2228 x 1652 pixels.
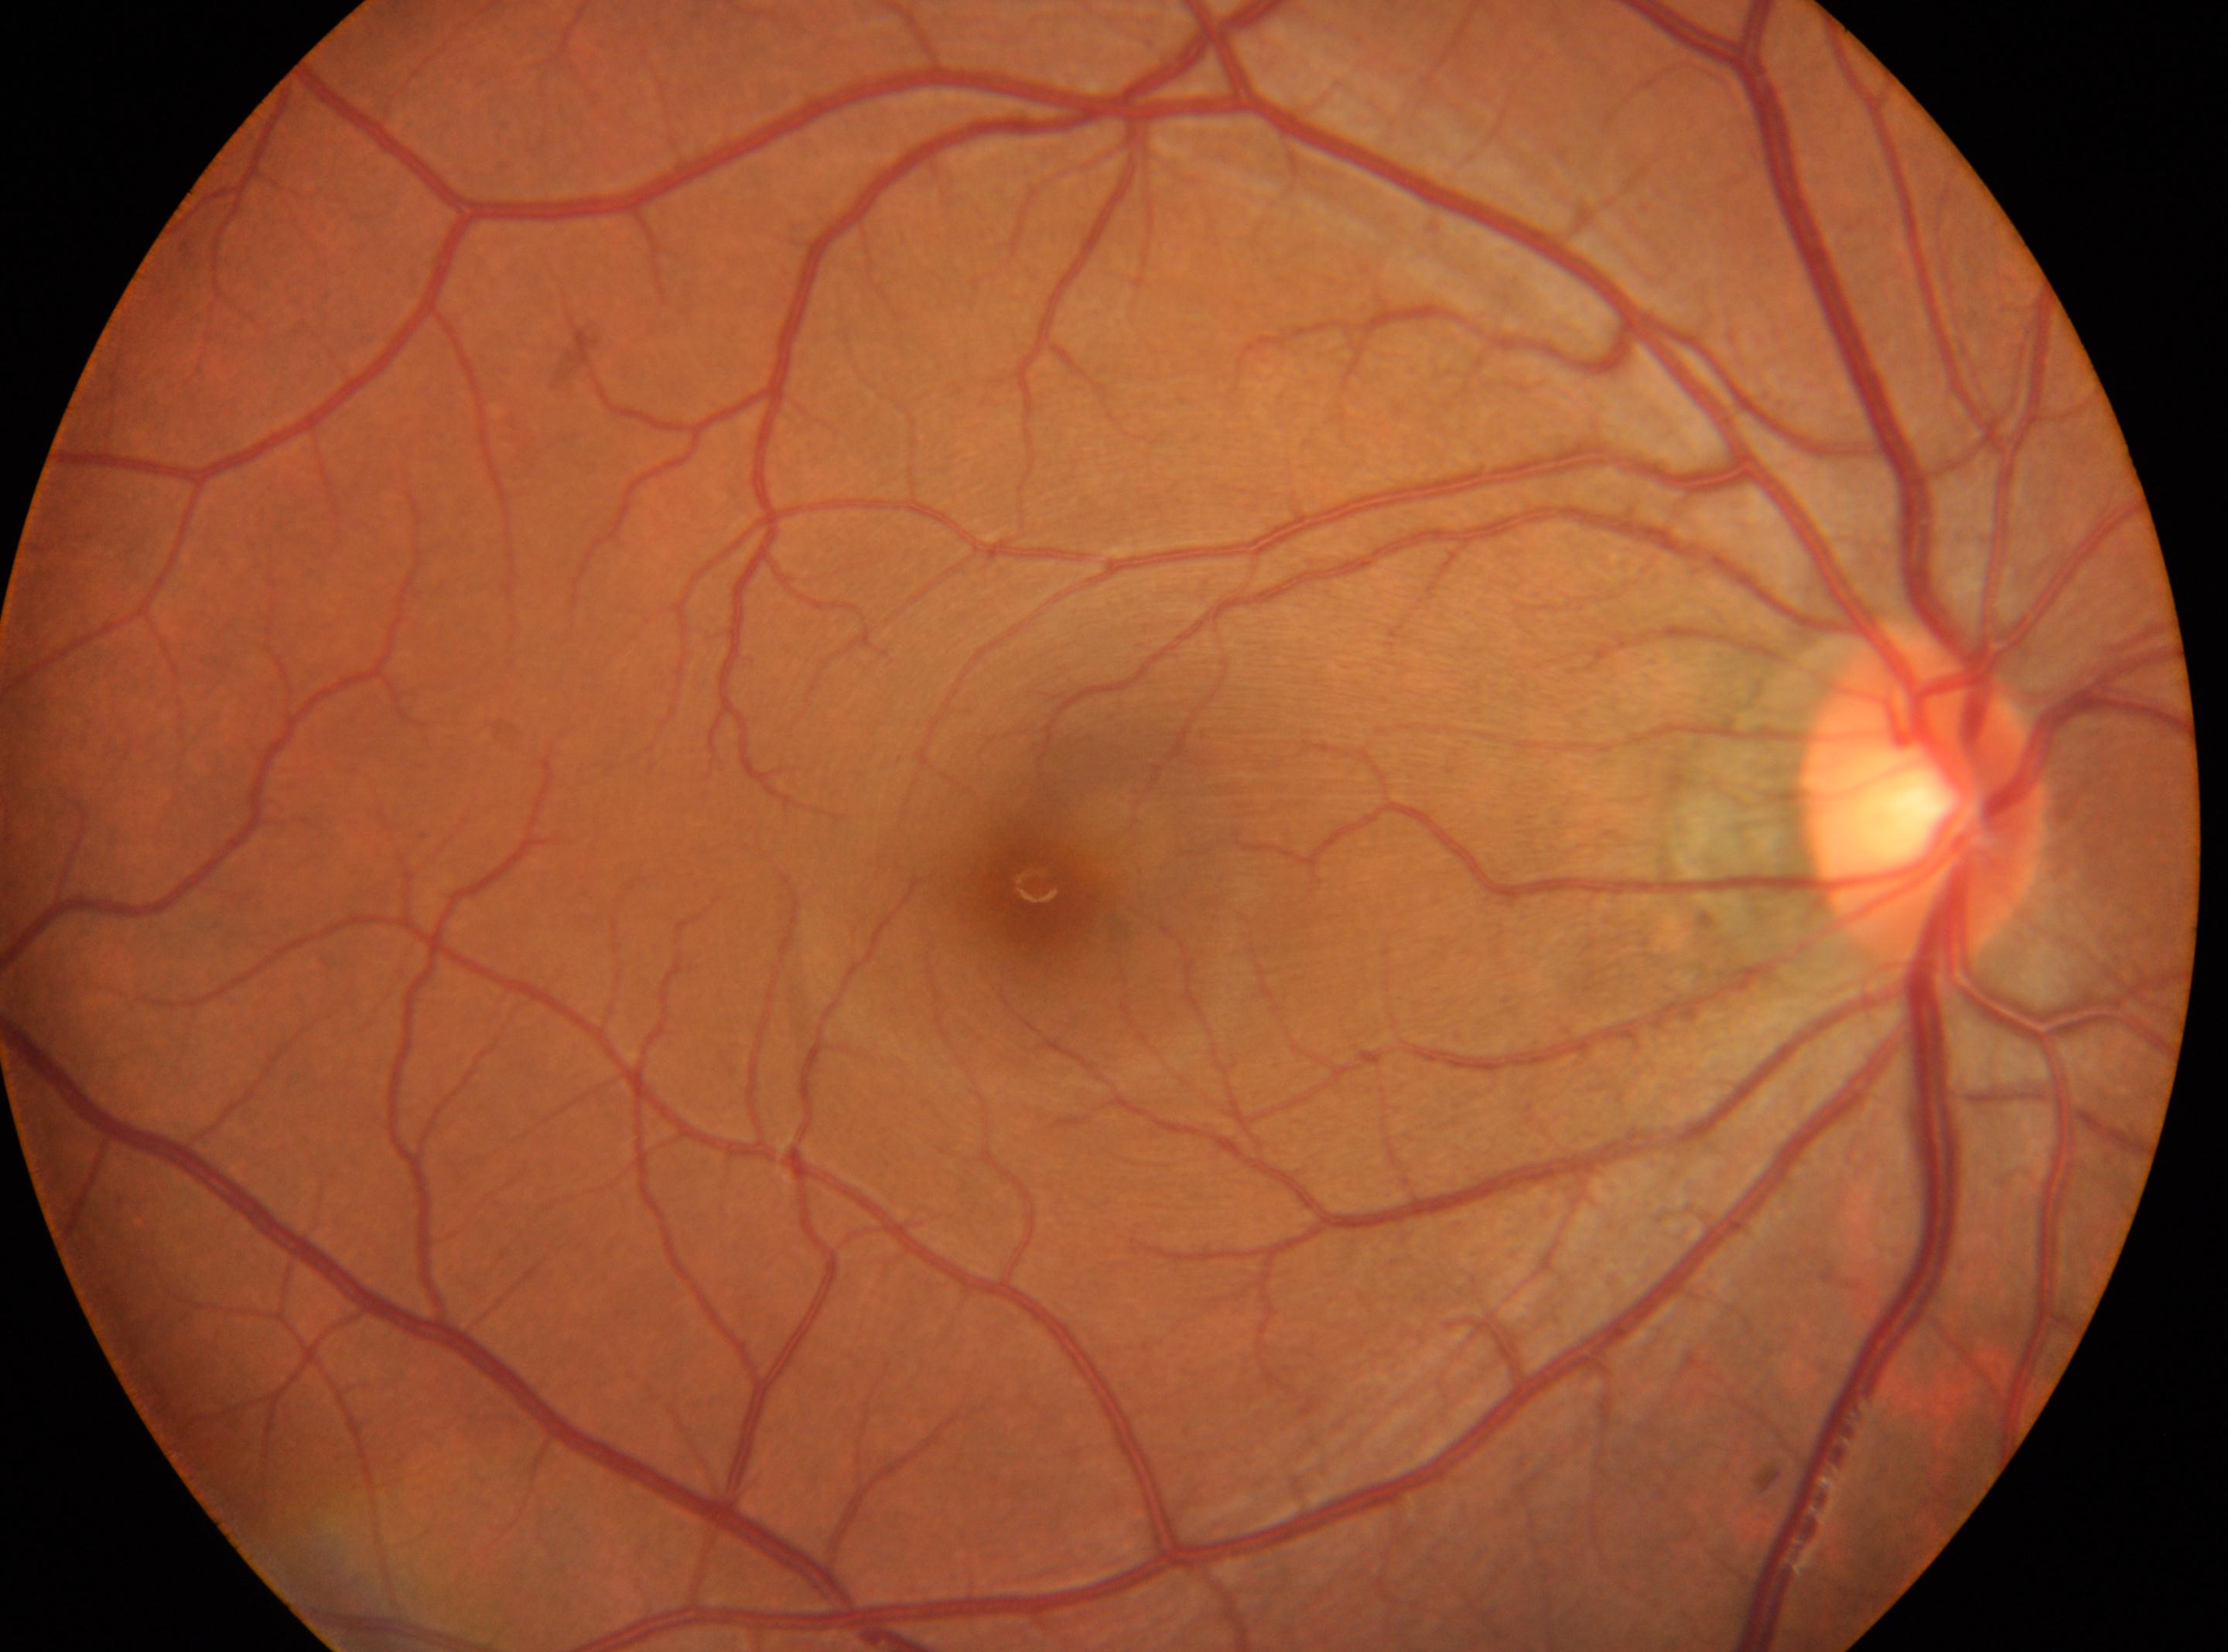
| feature | annotation |
|---|---|
| laterality | oculus dexter |
| optic nerve head | 1919px, 801px |
| macula center | 1043px, 886px |
| DR | grade 0 (no apparent retinopathy) |